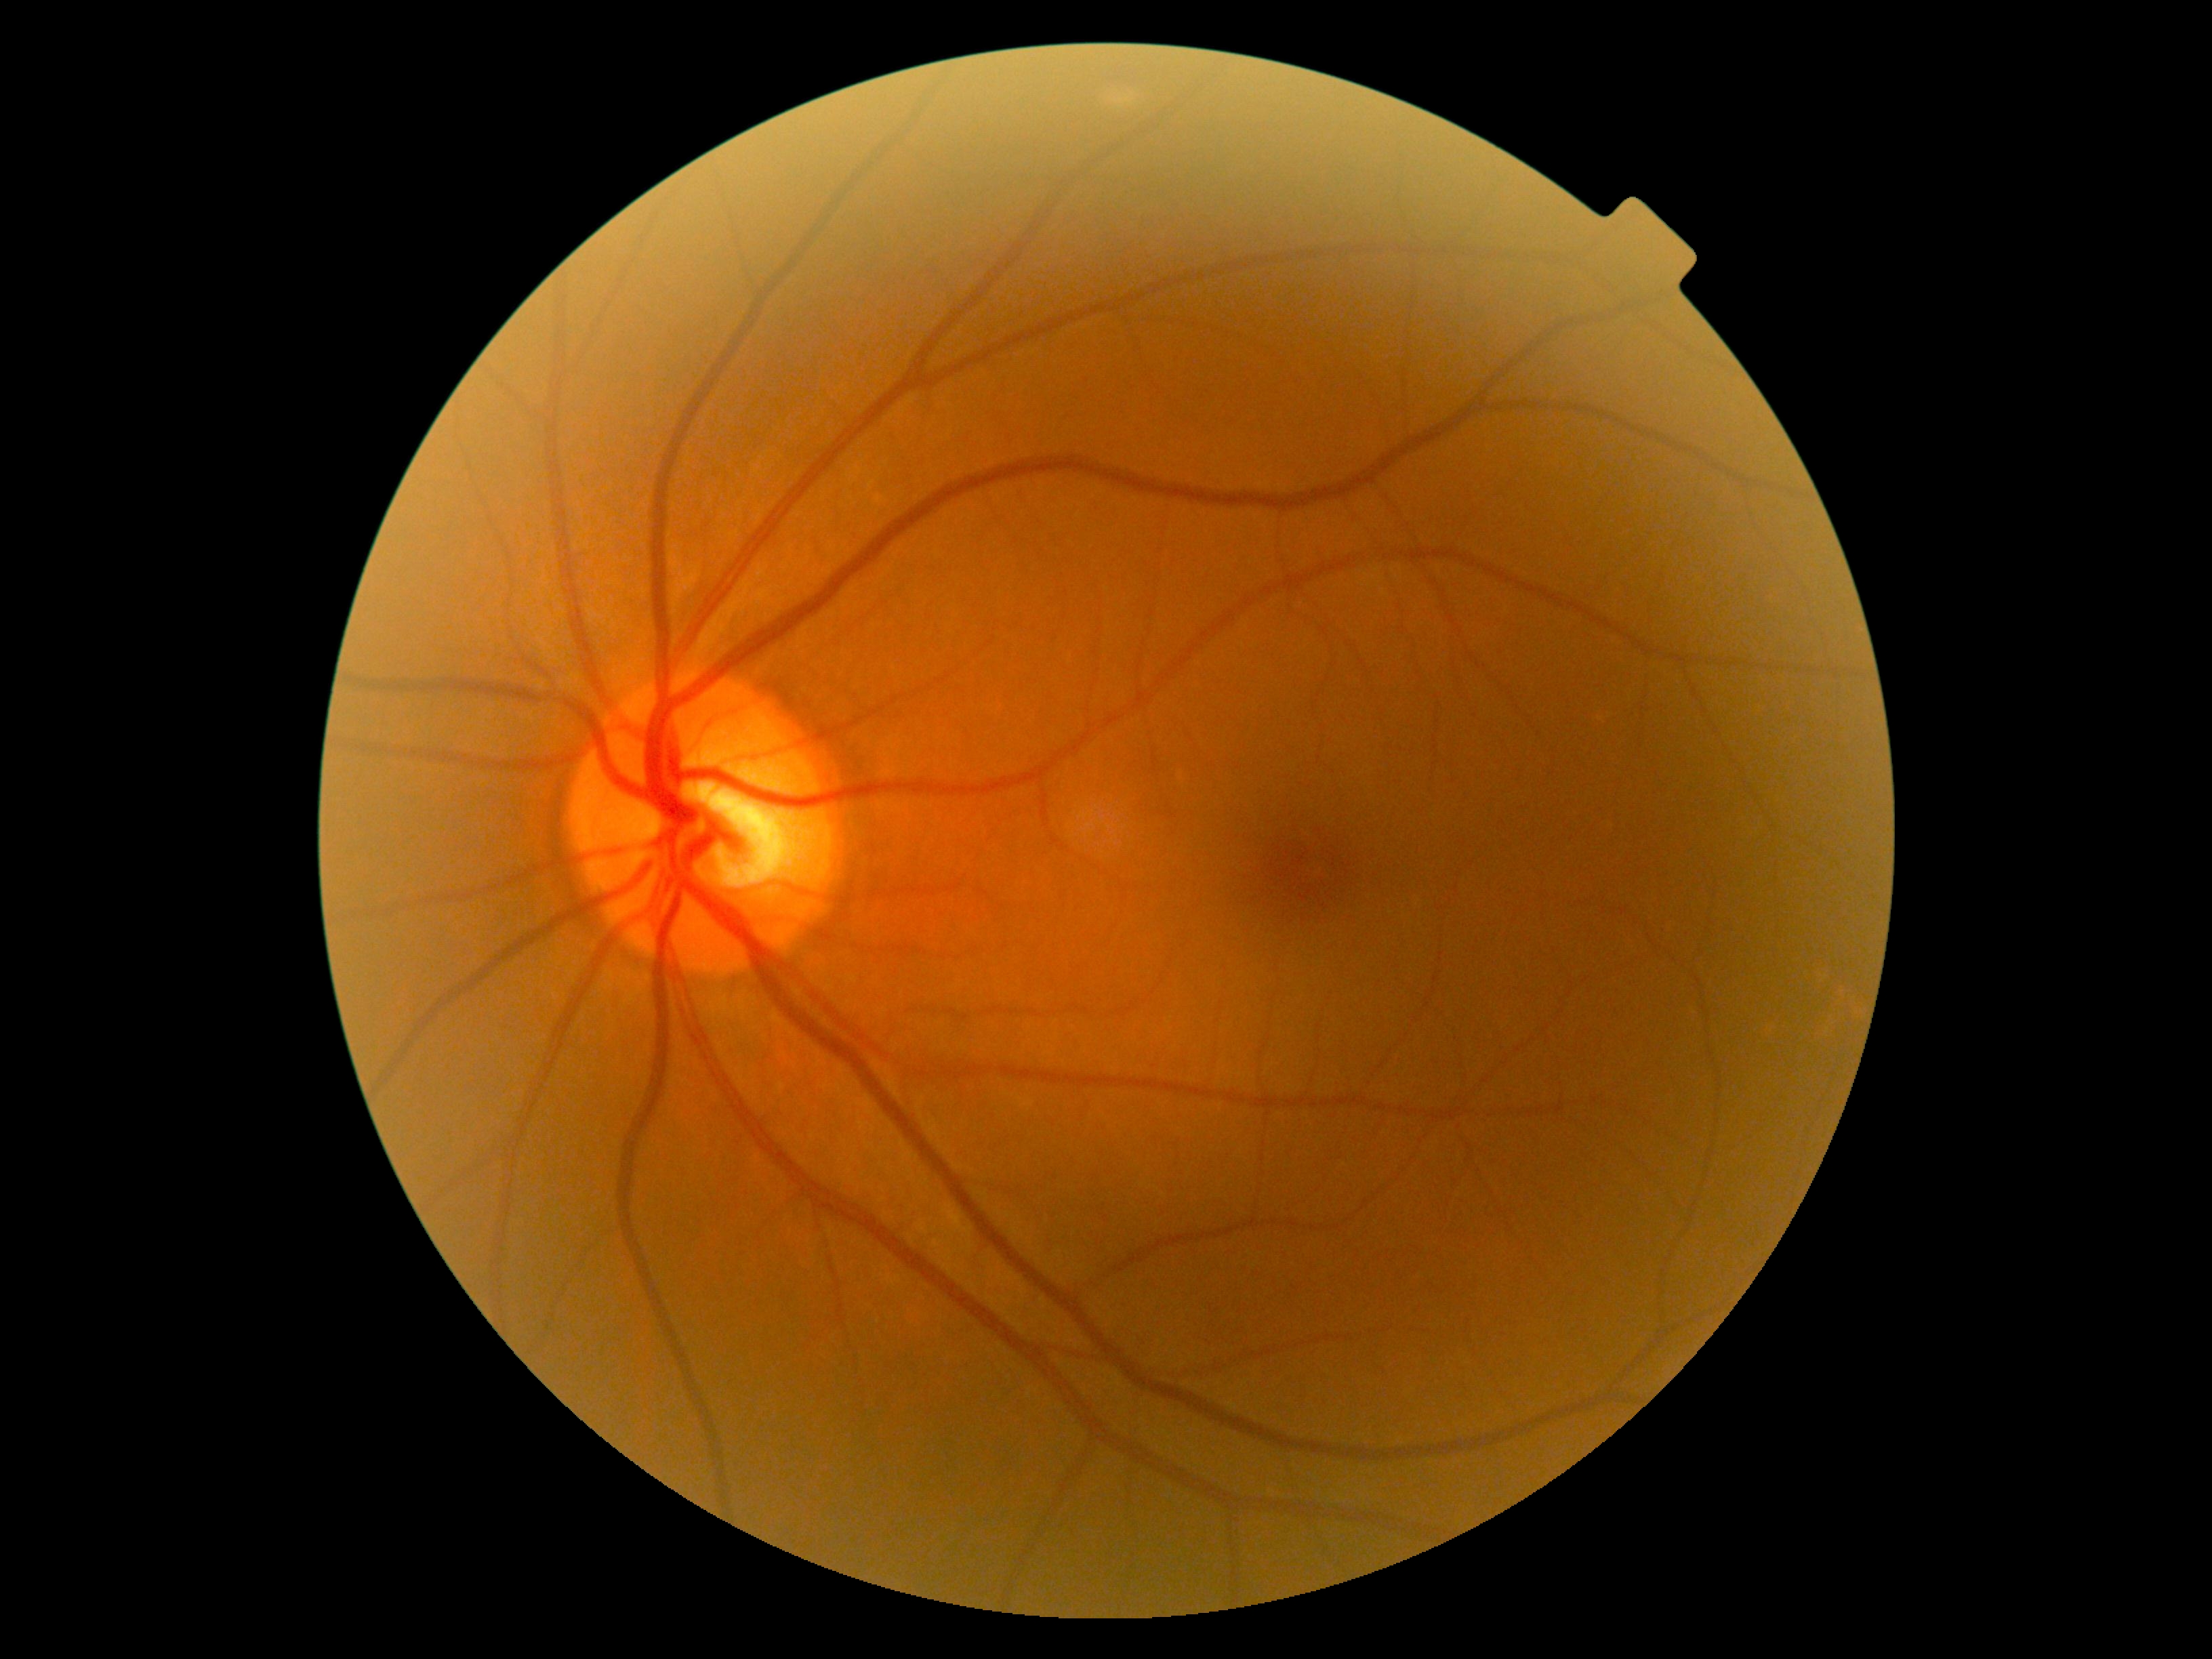

diabetic retinopathy grade: 0 (no apparent retinopathy).